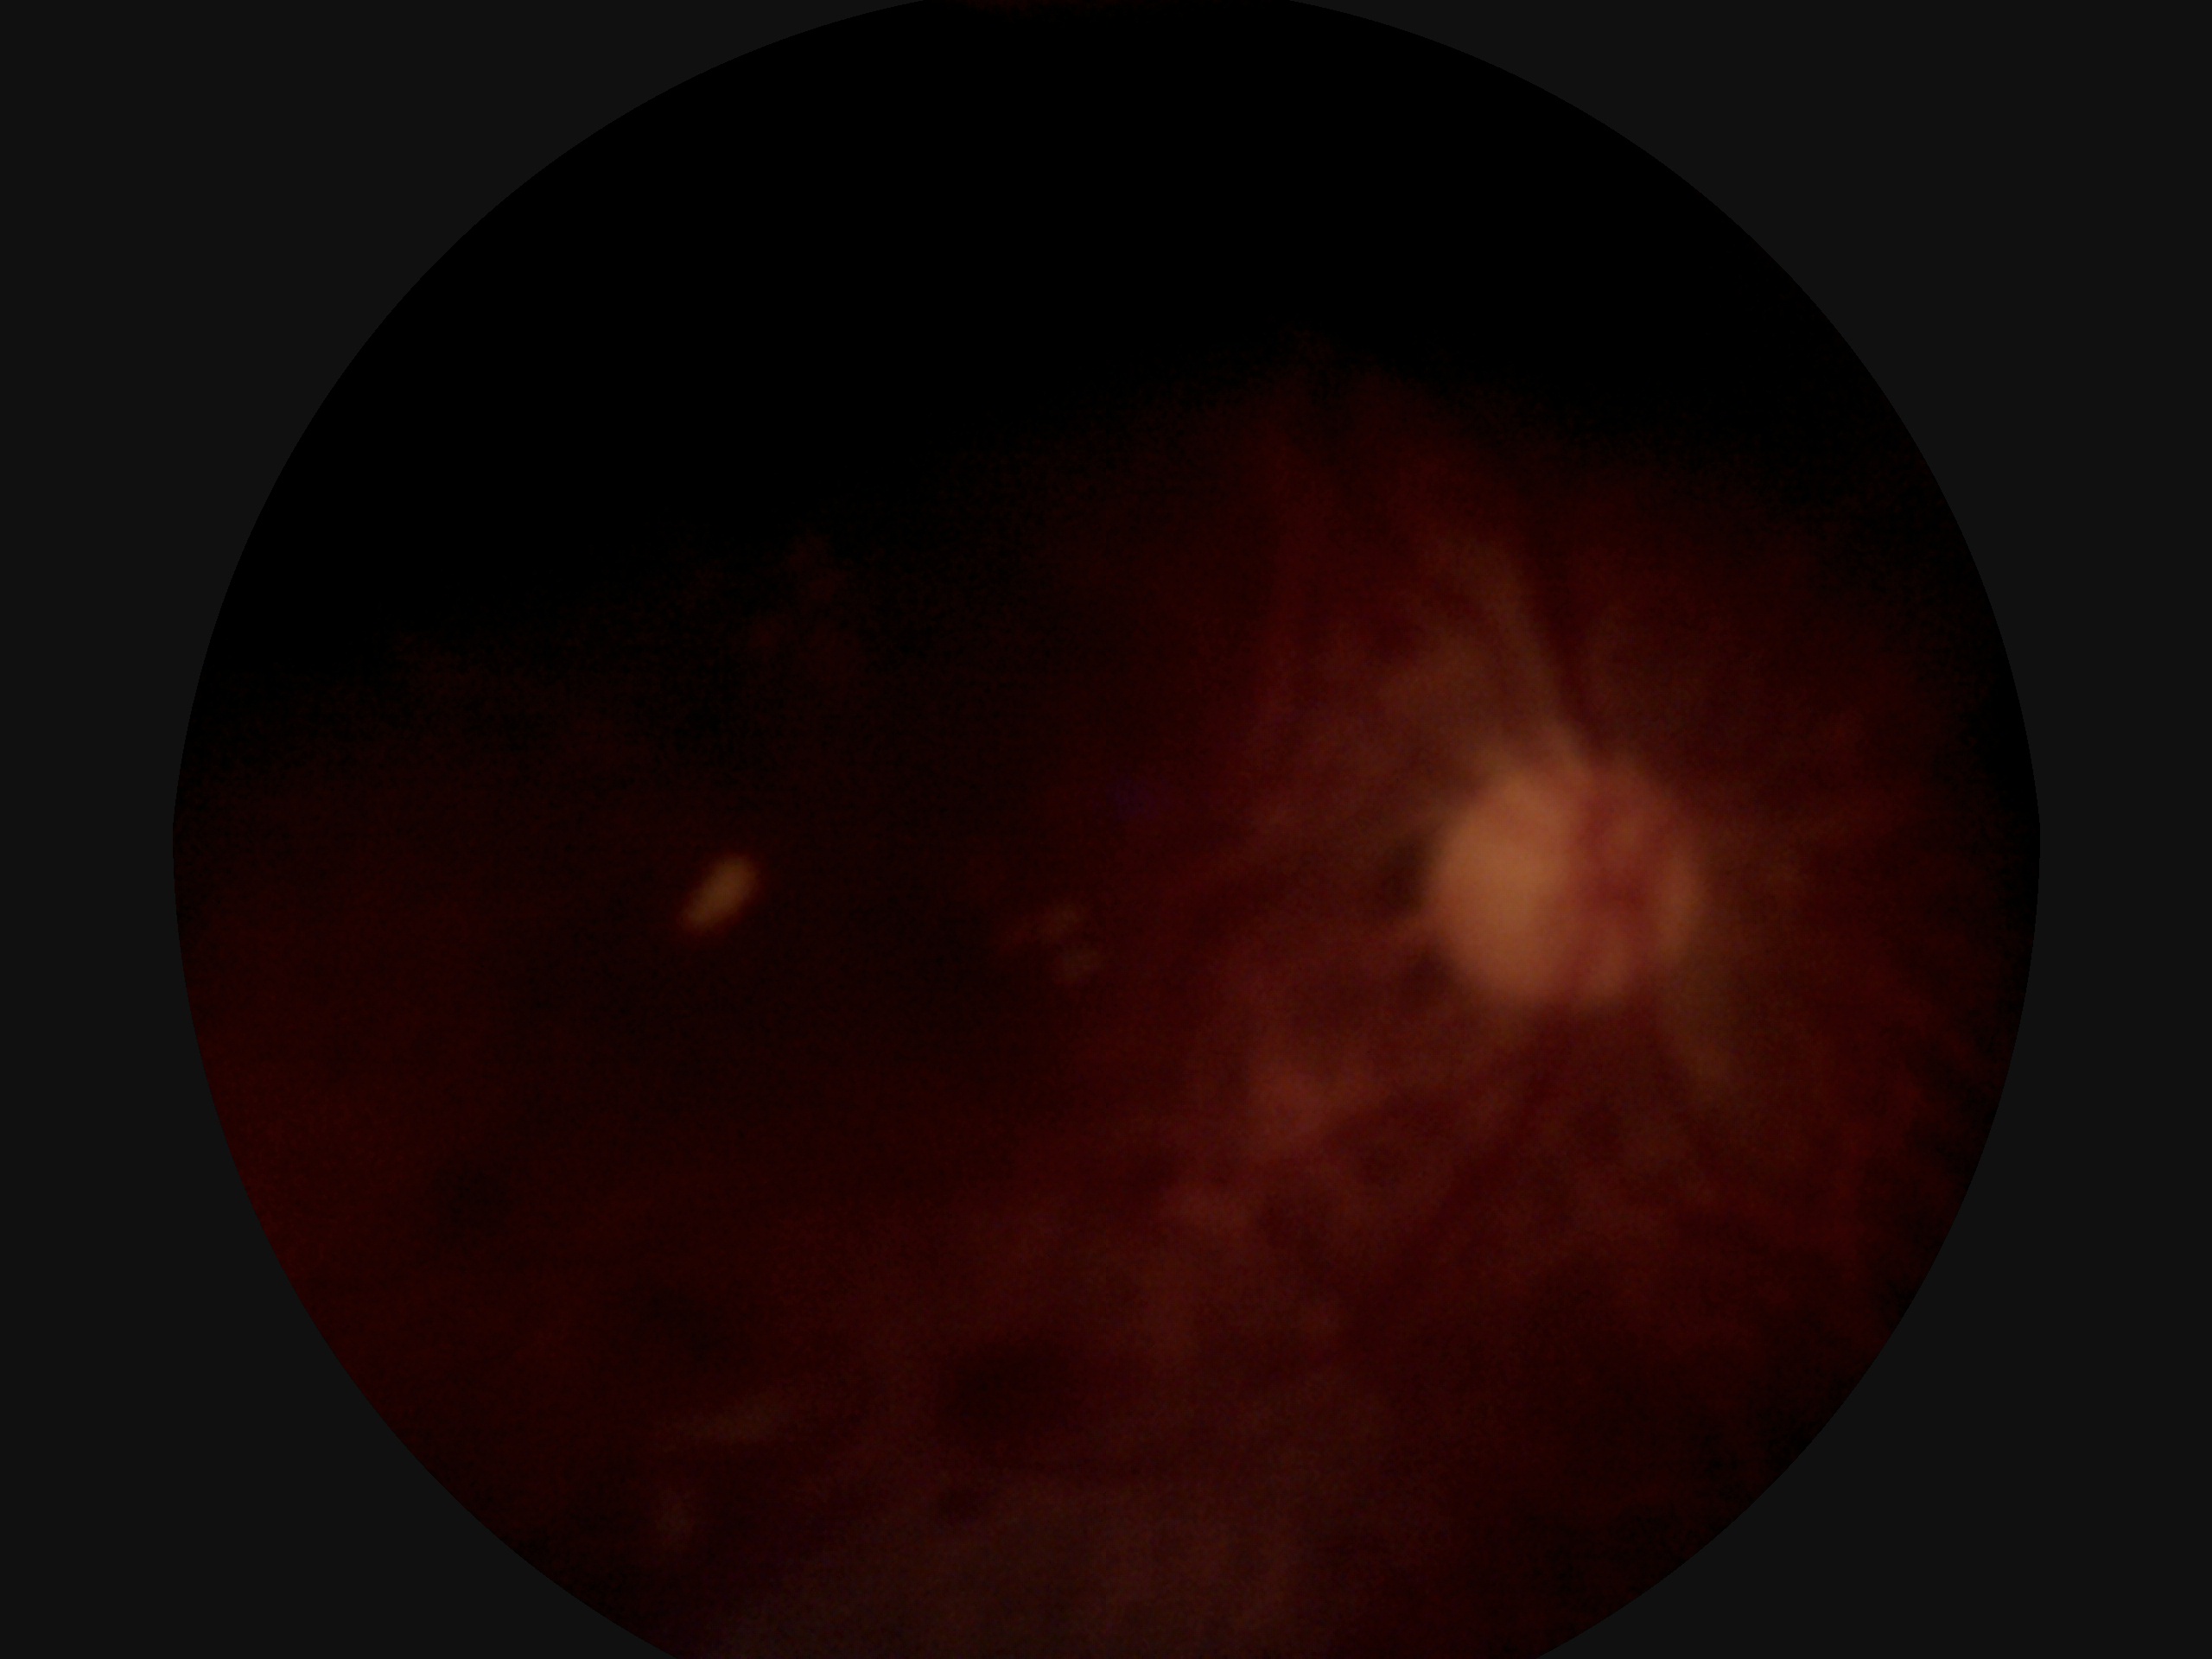
DR is ungradable.